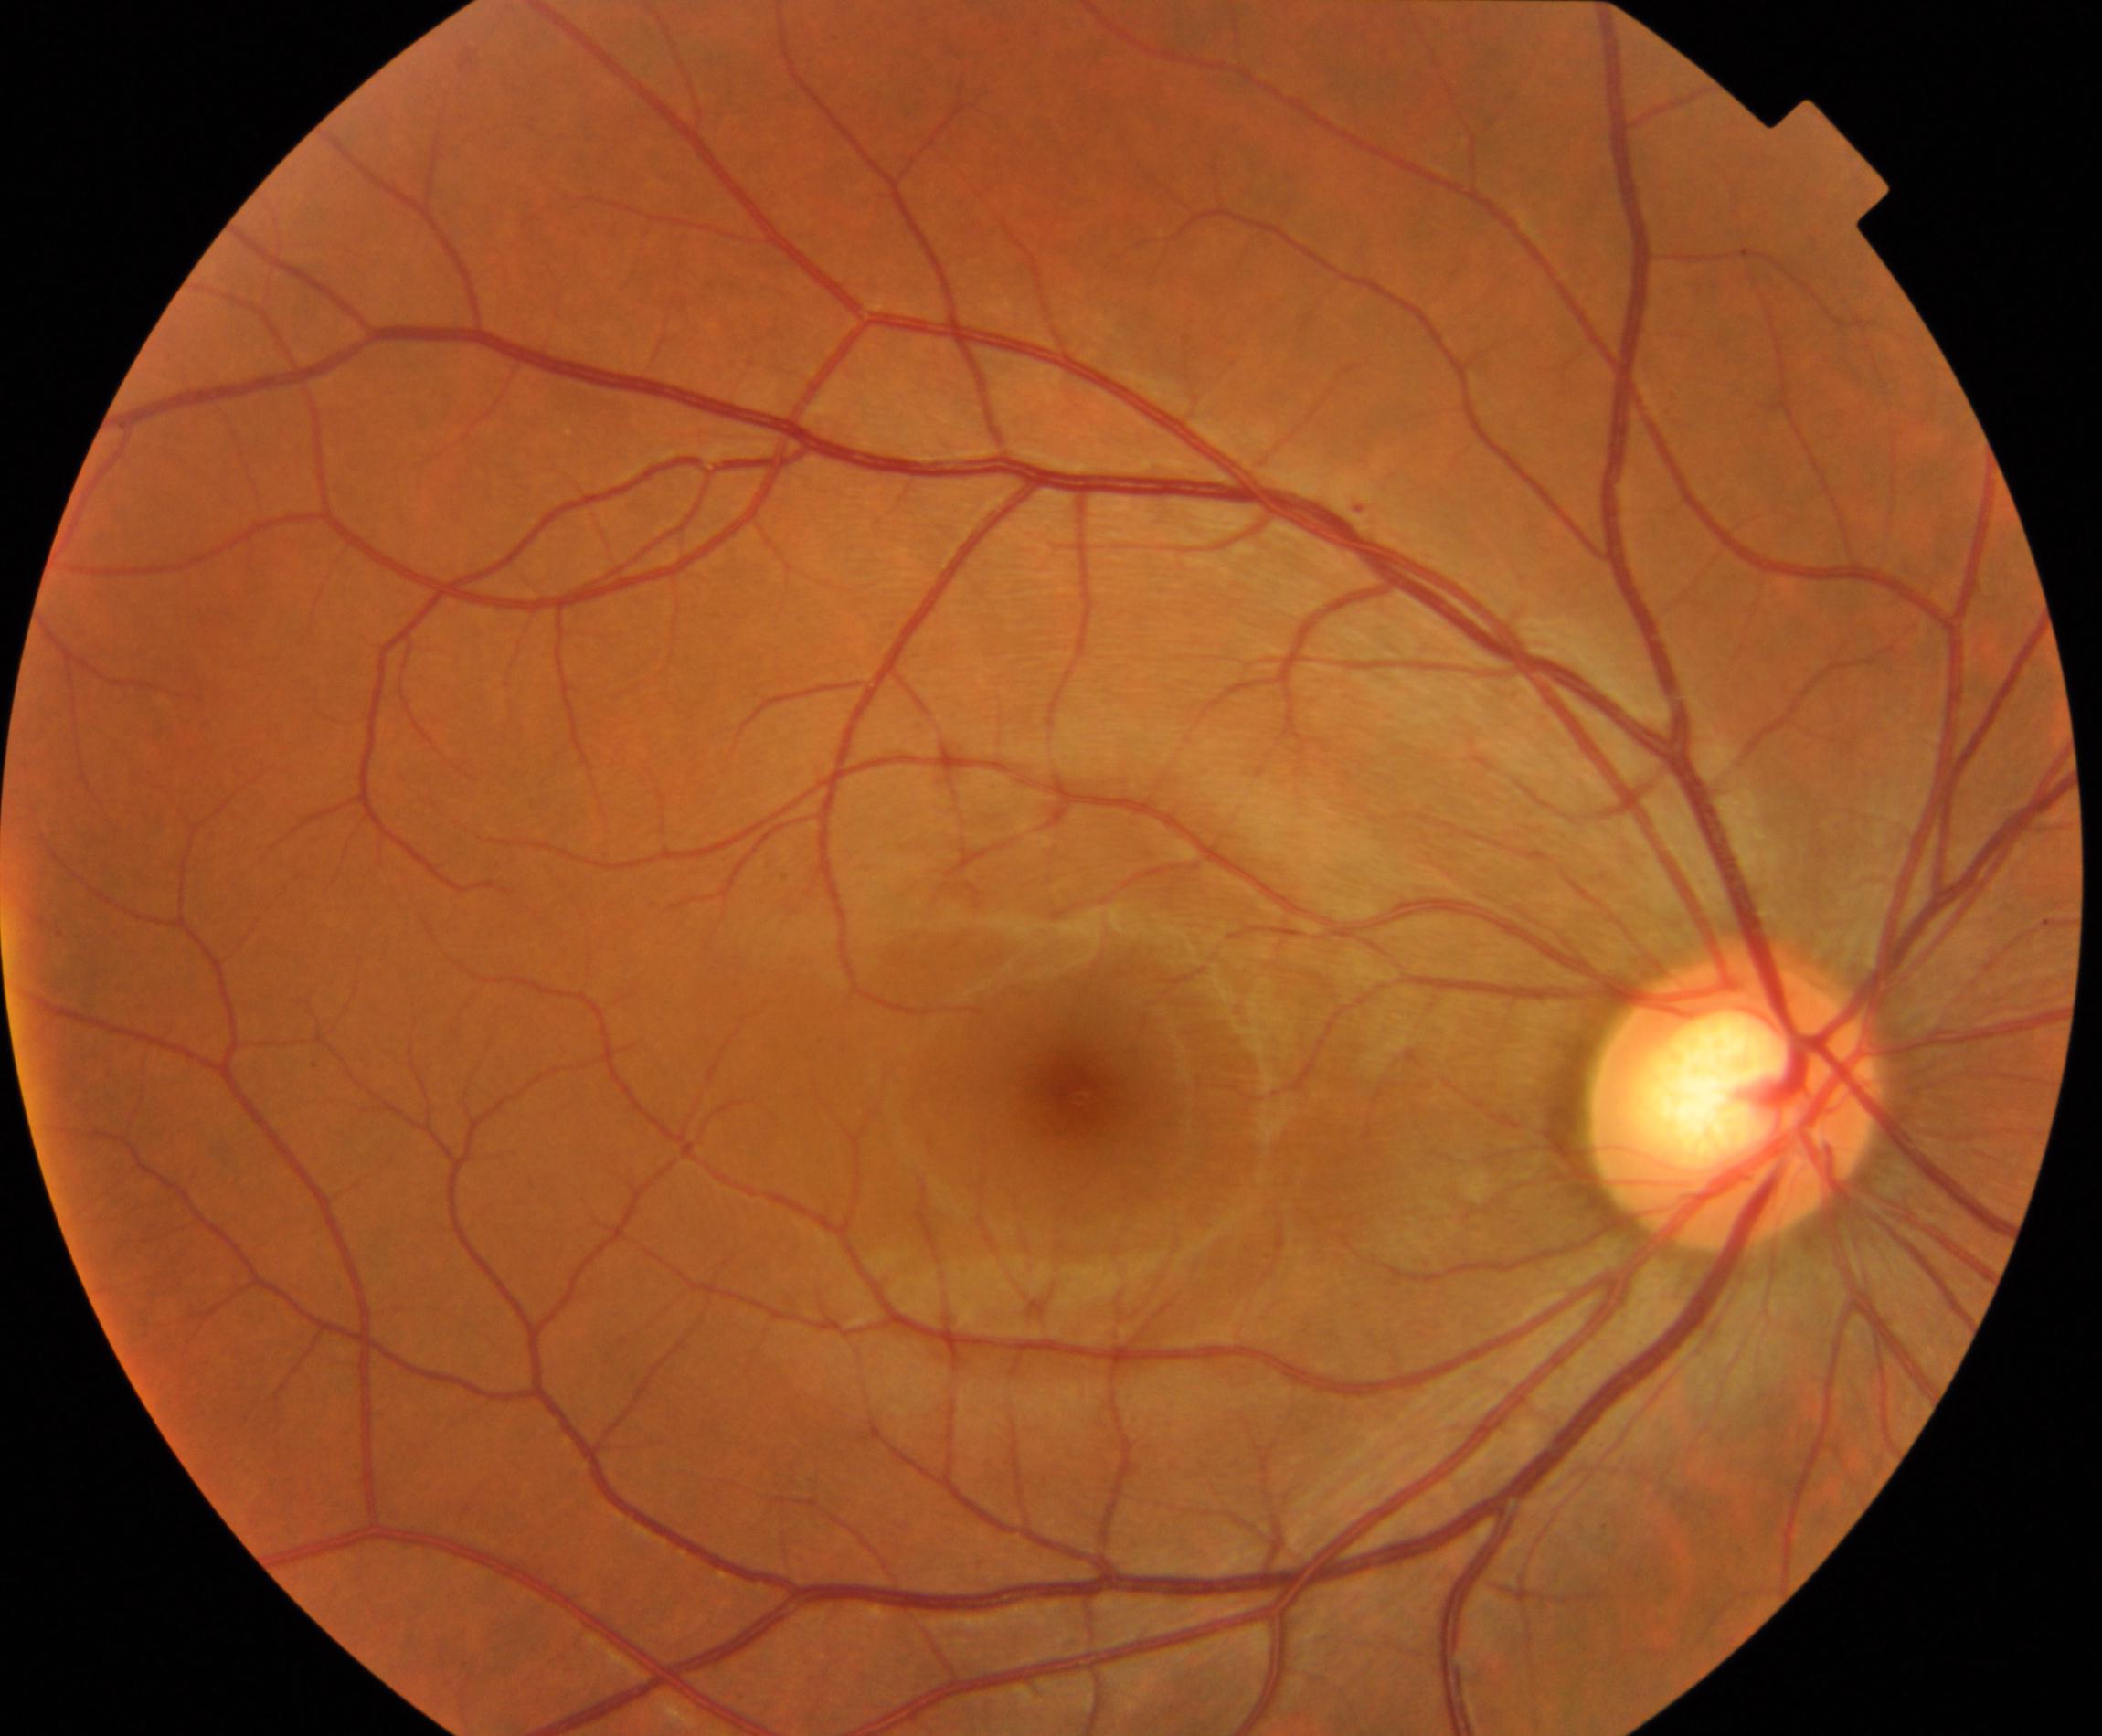 Diagnosis: large optic cup.